RetCam wide-field infant fundus image; acquired on the Clarity RetCam 3; image size 640x480: 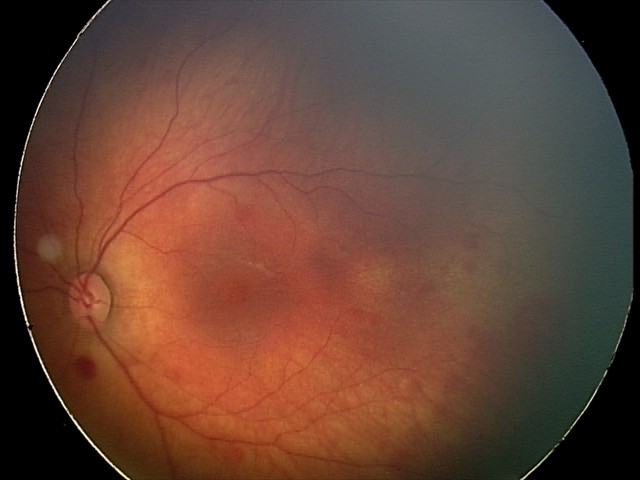 From an examination with diagnosis of retinal hemorrhages.